Acquired with a Forus 3Nethra Classic · fundus photo — 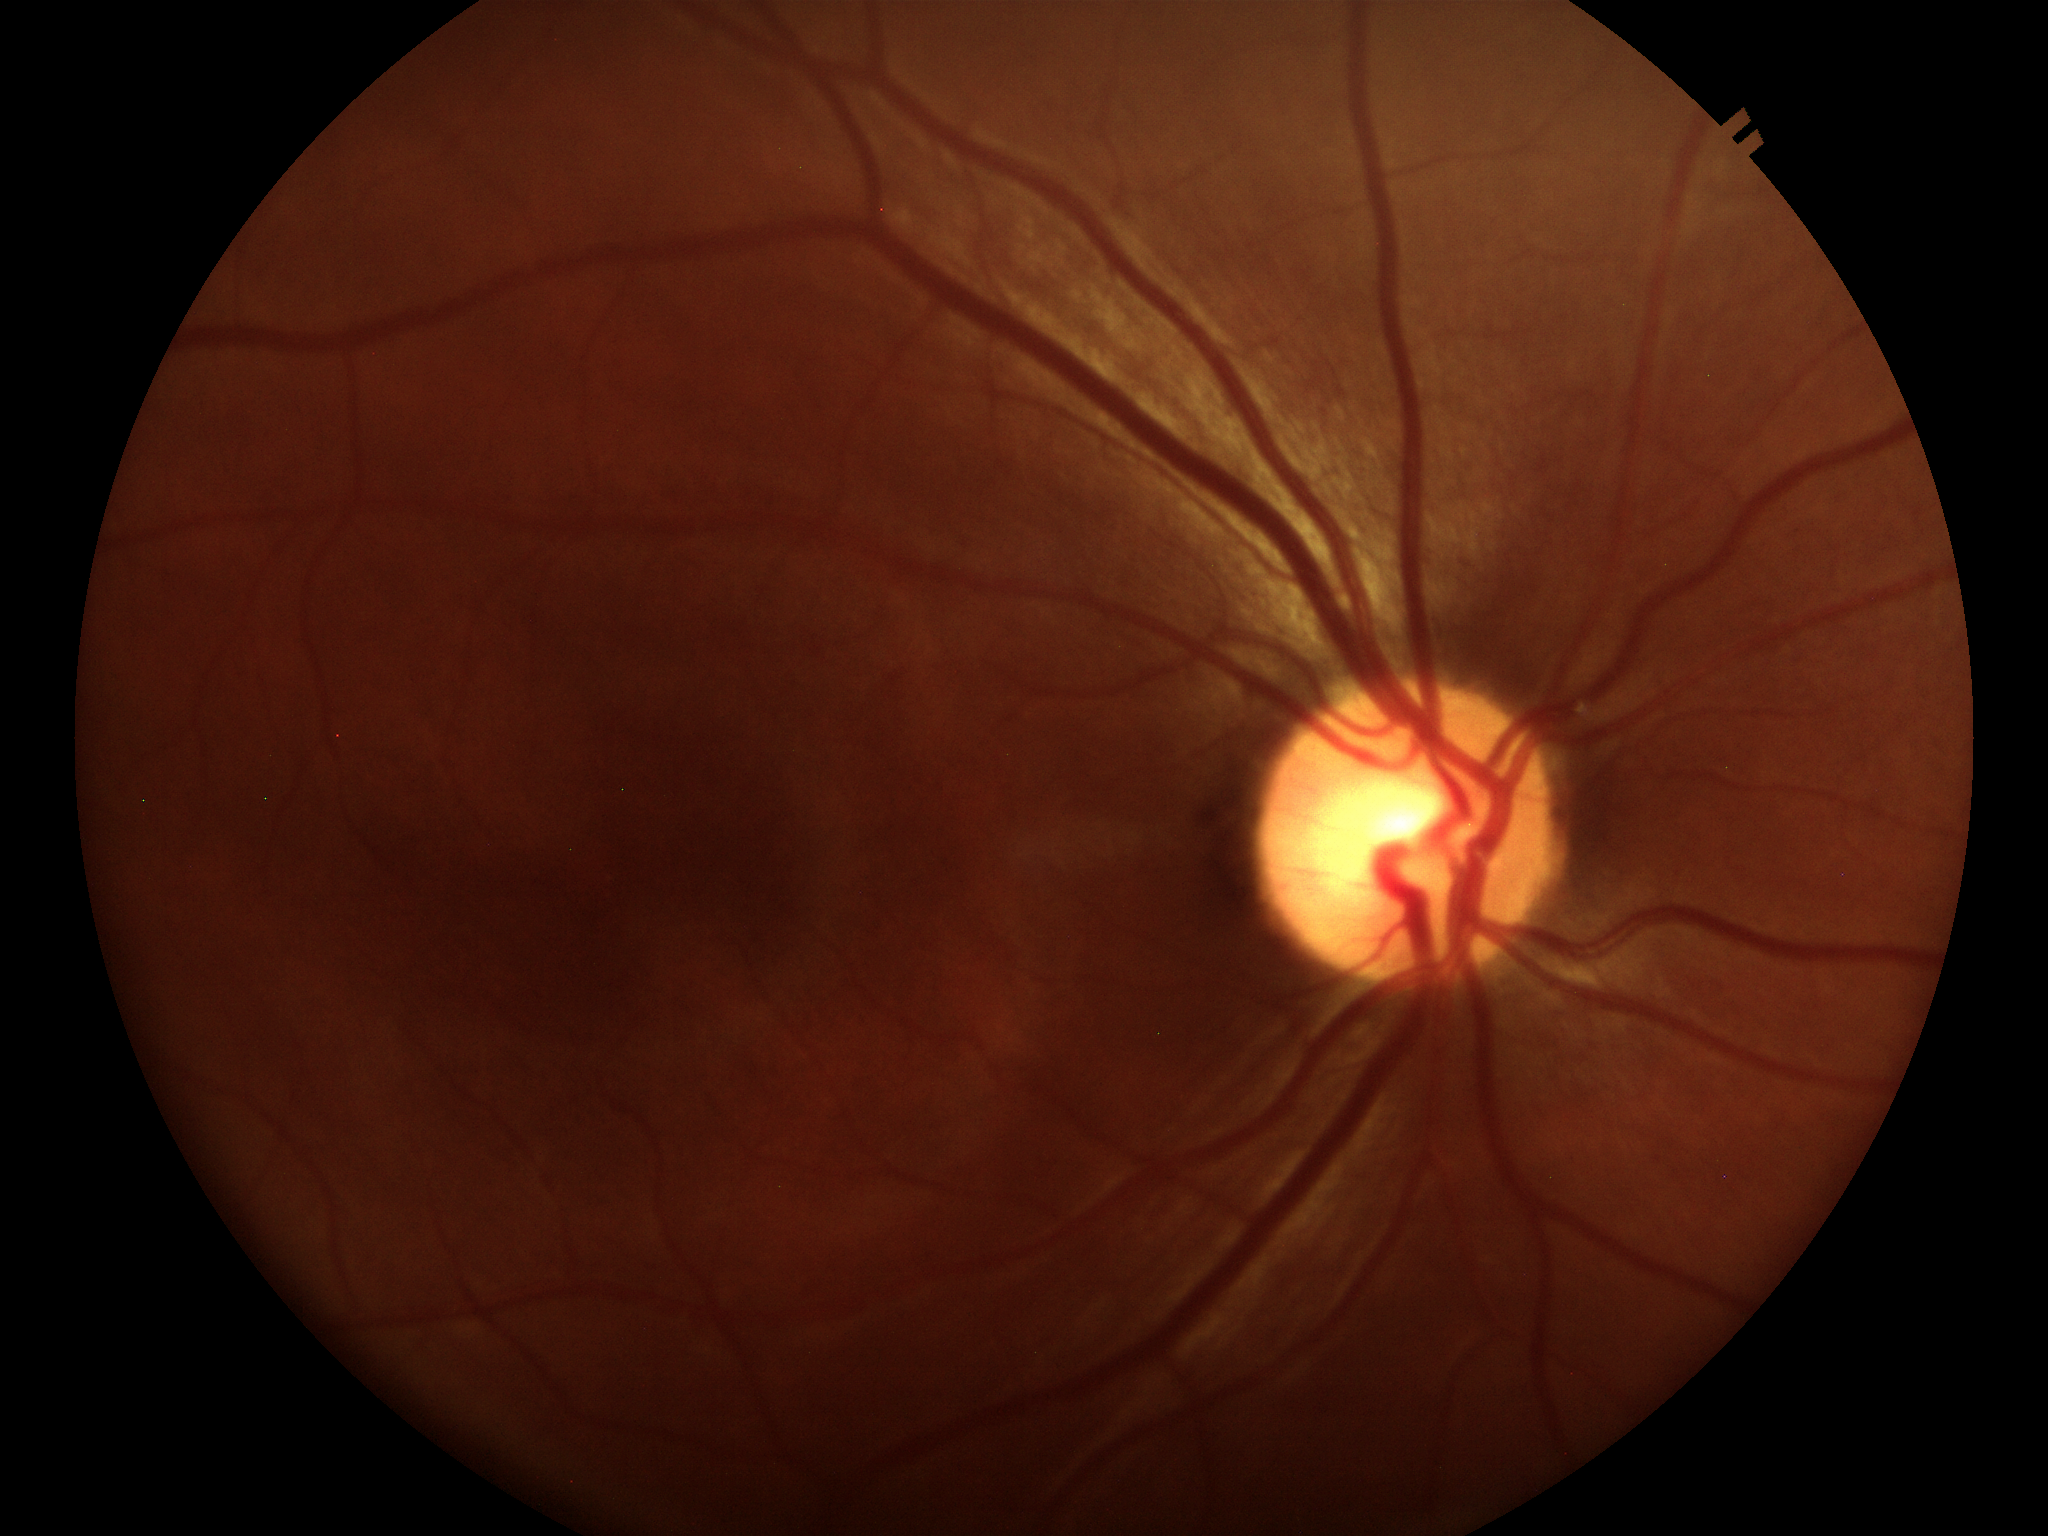 Negative for glaucoma suspicion. Vertical cup-to-disc ratio of 0.46. Horizontal cup-disc ratio is 0.55.